Retinal fundus photograph: 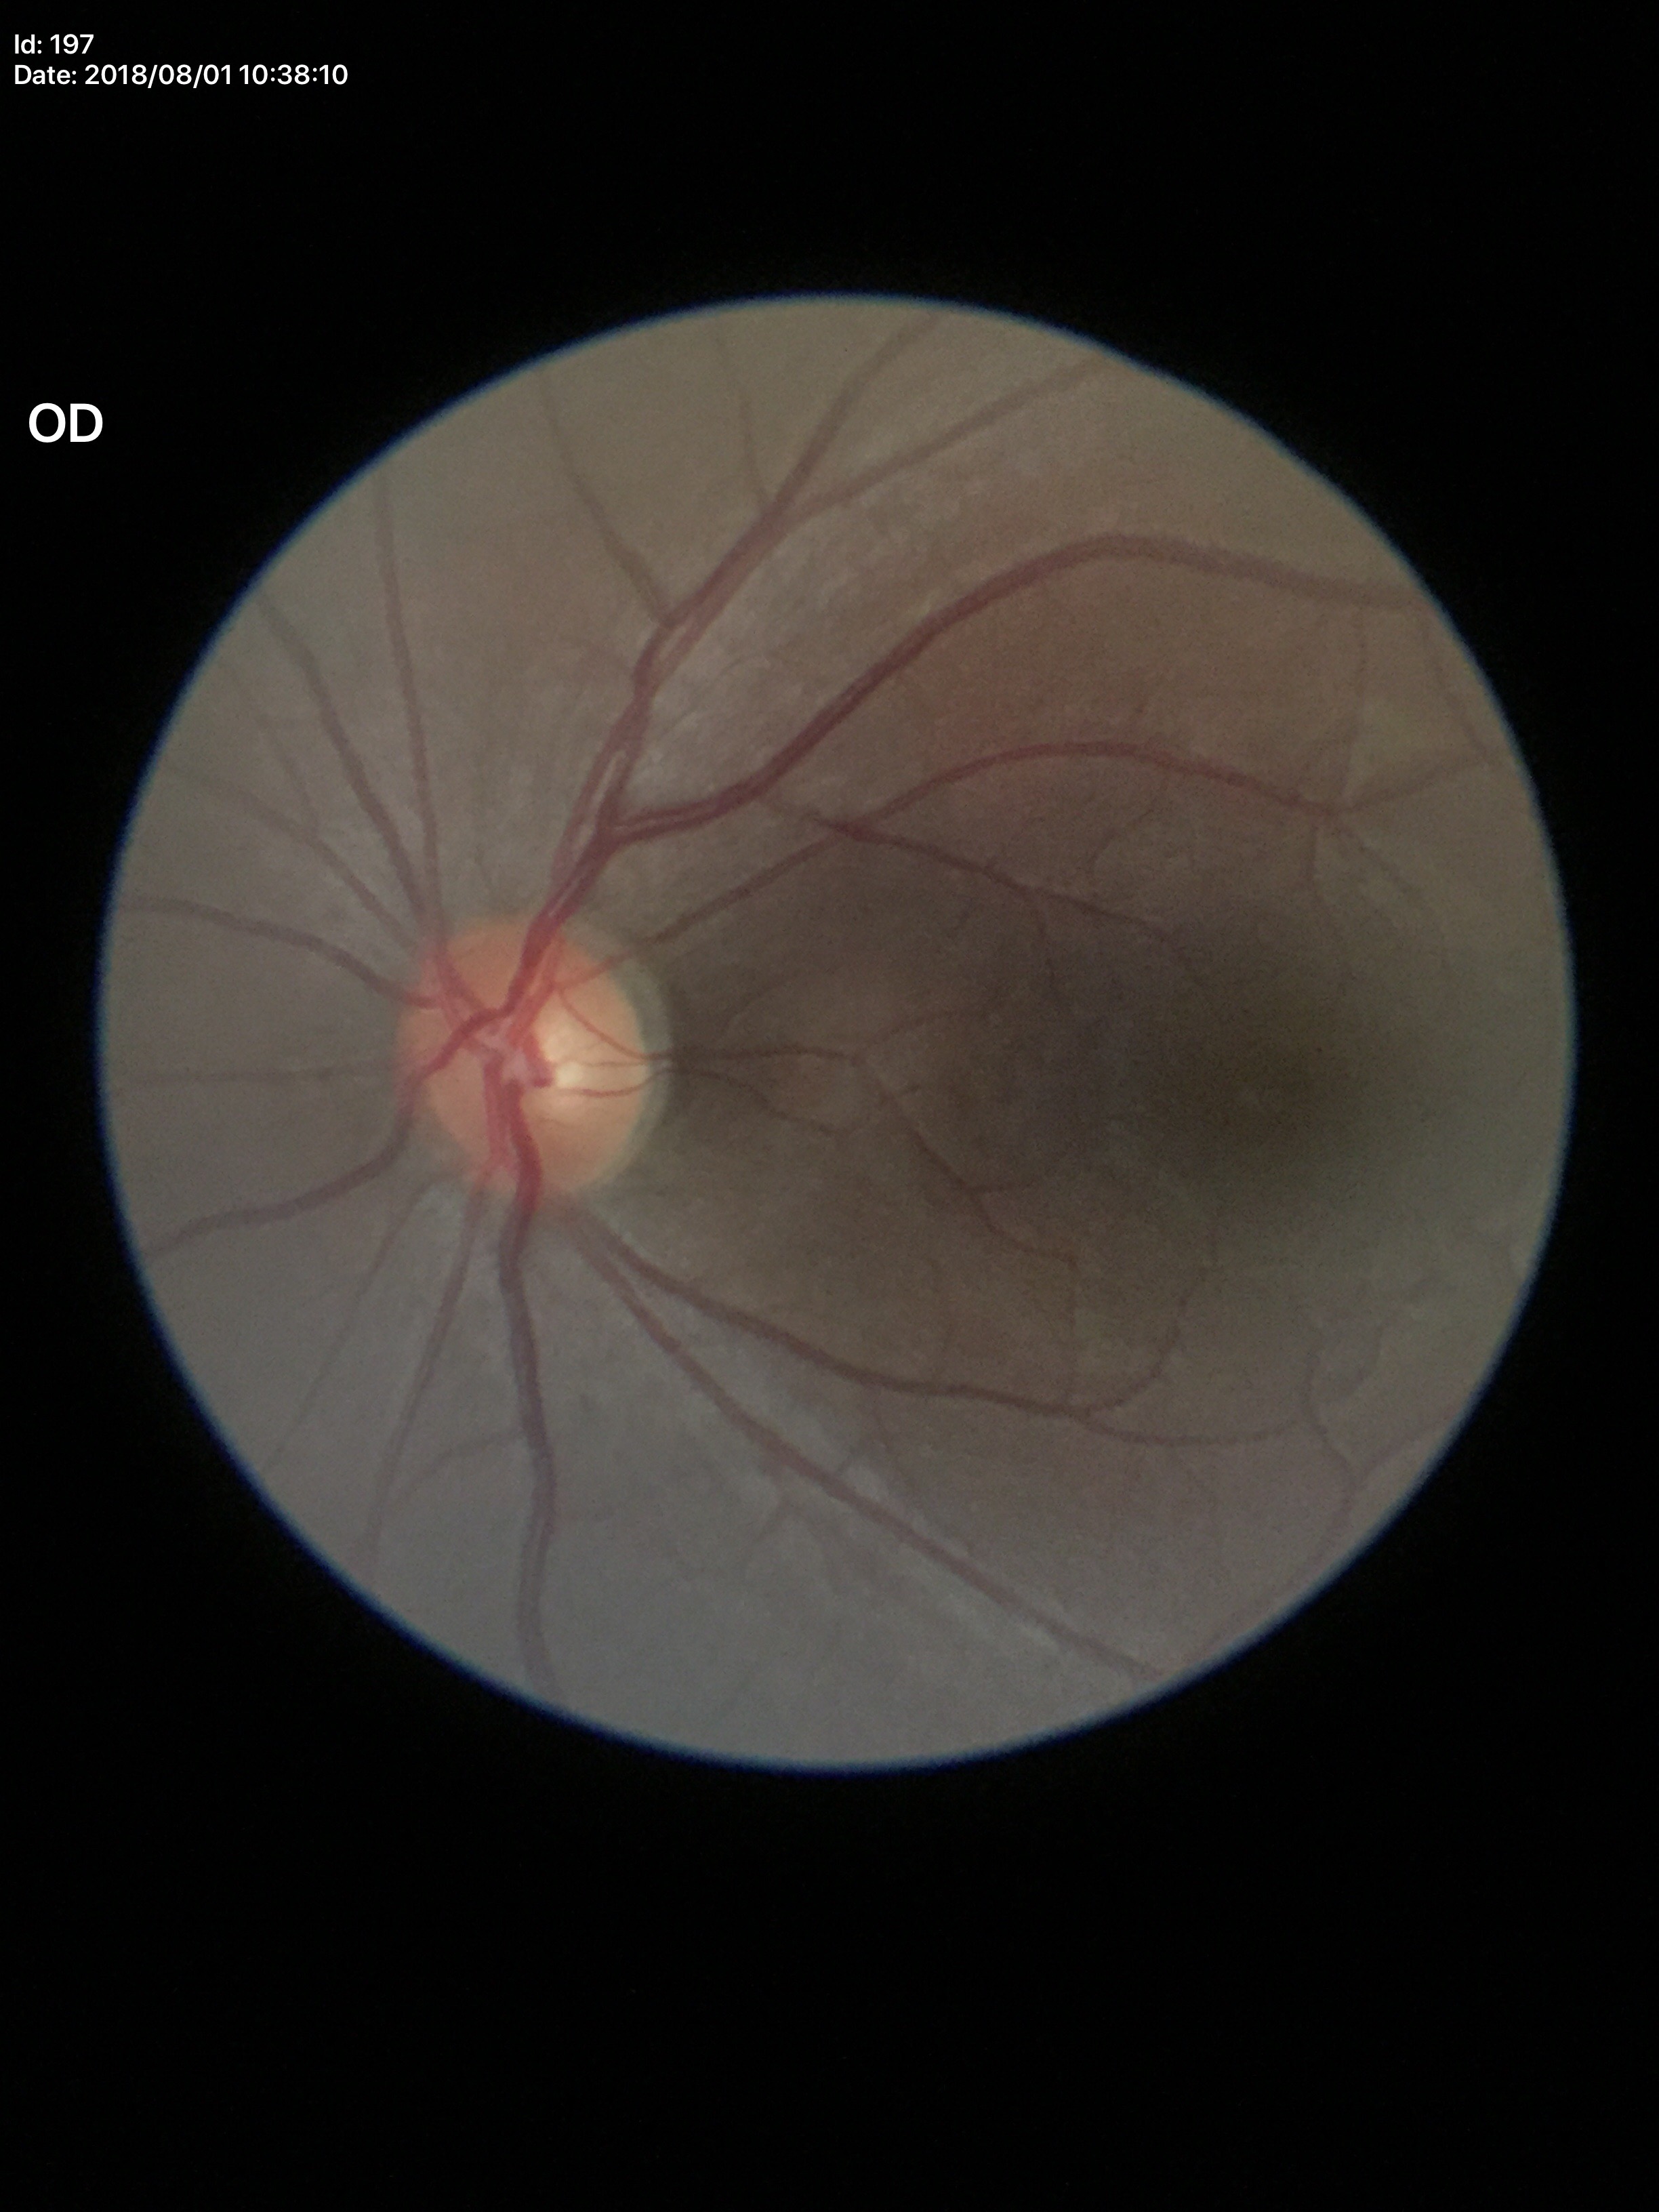 Glaucoma impression: not suspect (unanimous normal call). Vertical cup-to-disc ratio: 0.48.